Pediatric retinal photograph (wide-field).
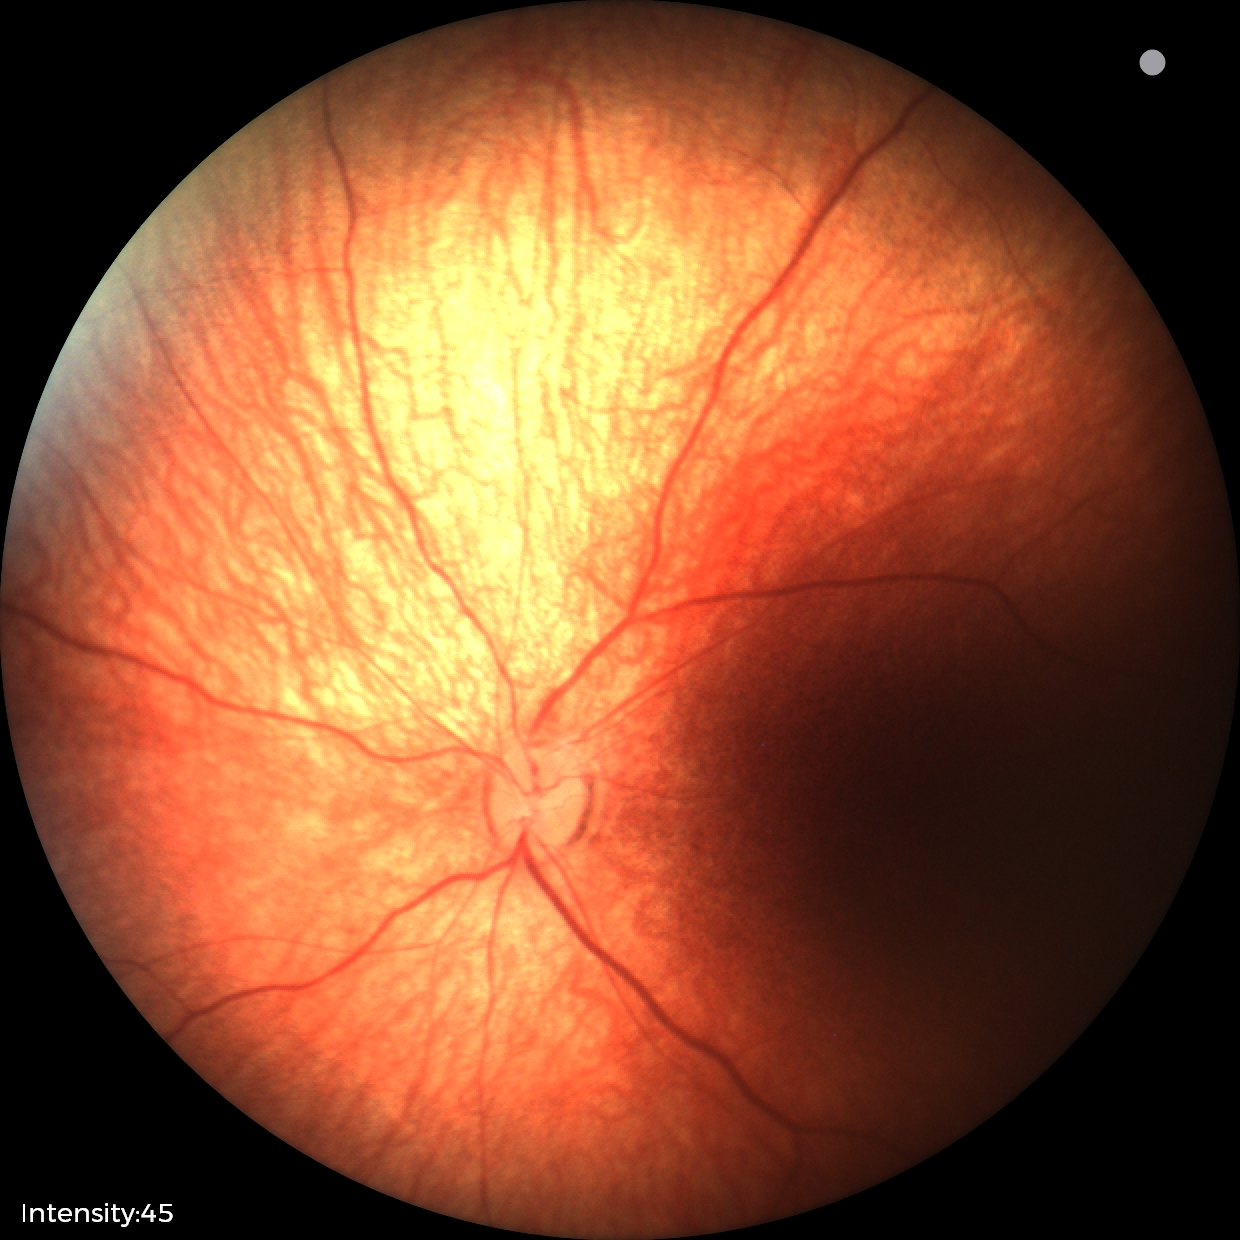 Examination with physiological retinal findings.